Image size 2212x1659 · CFP: 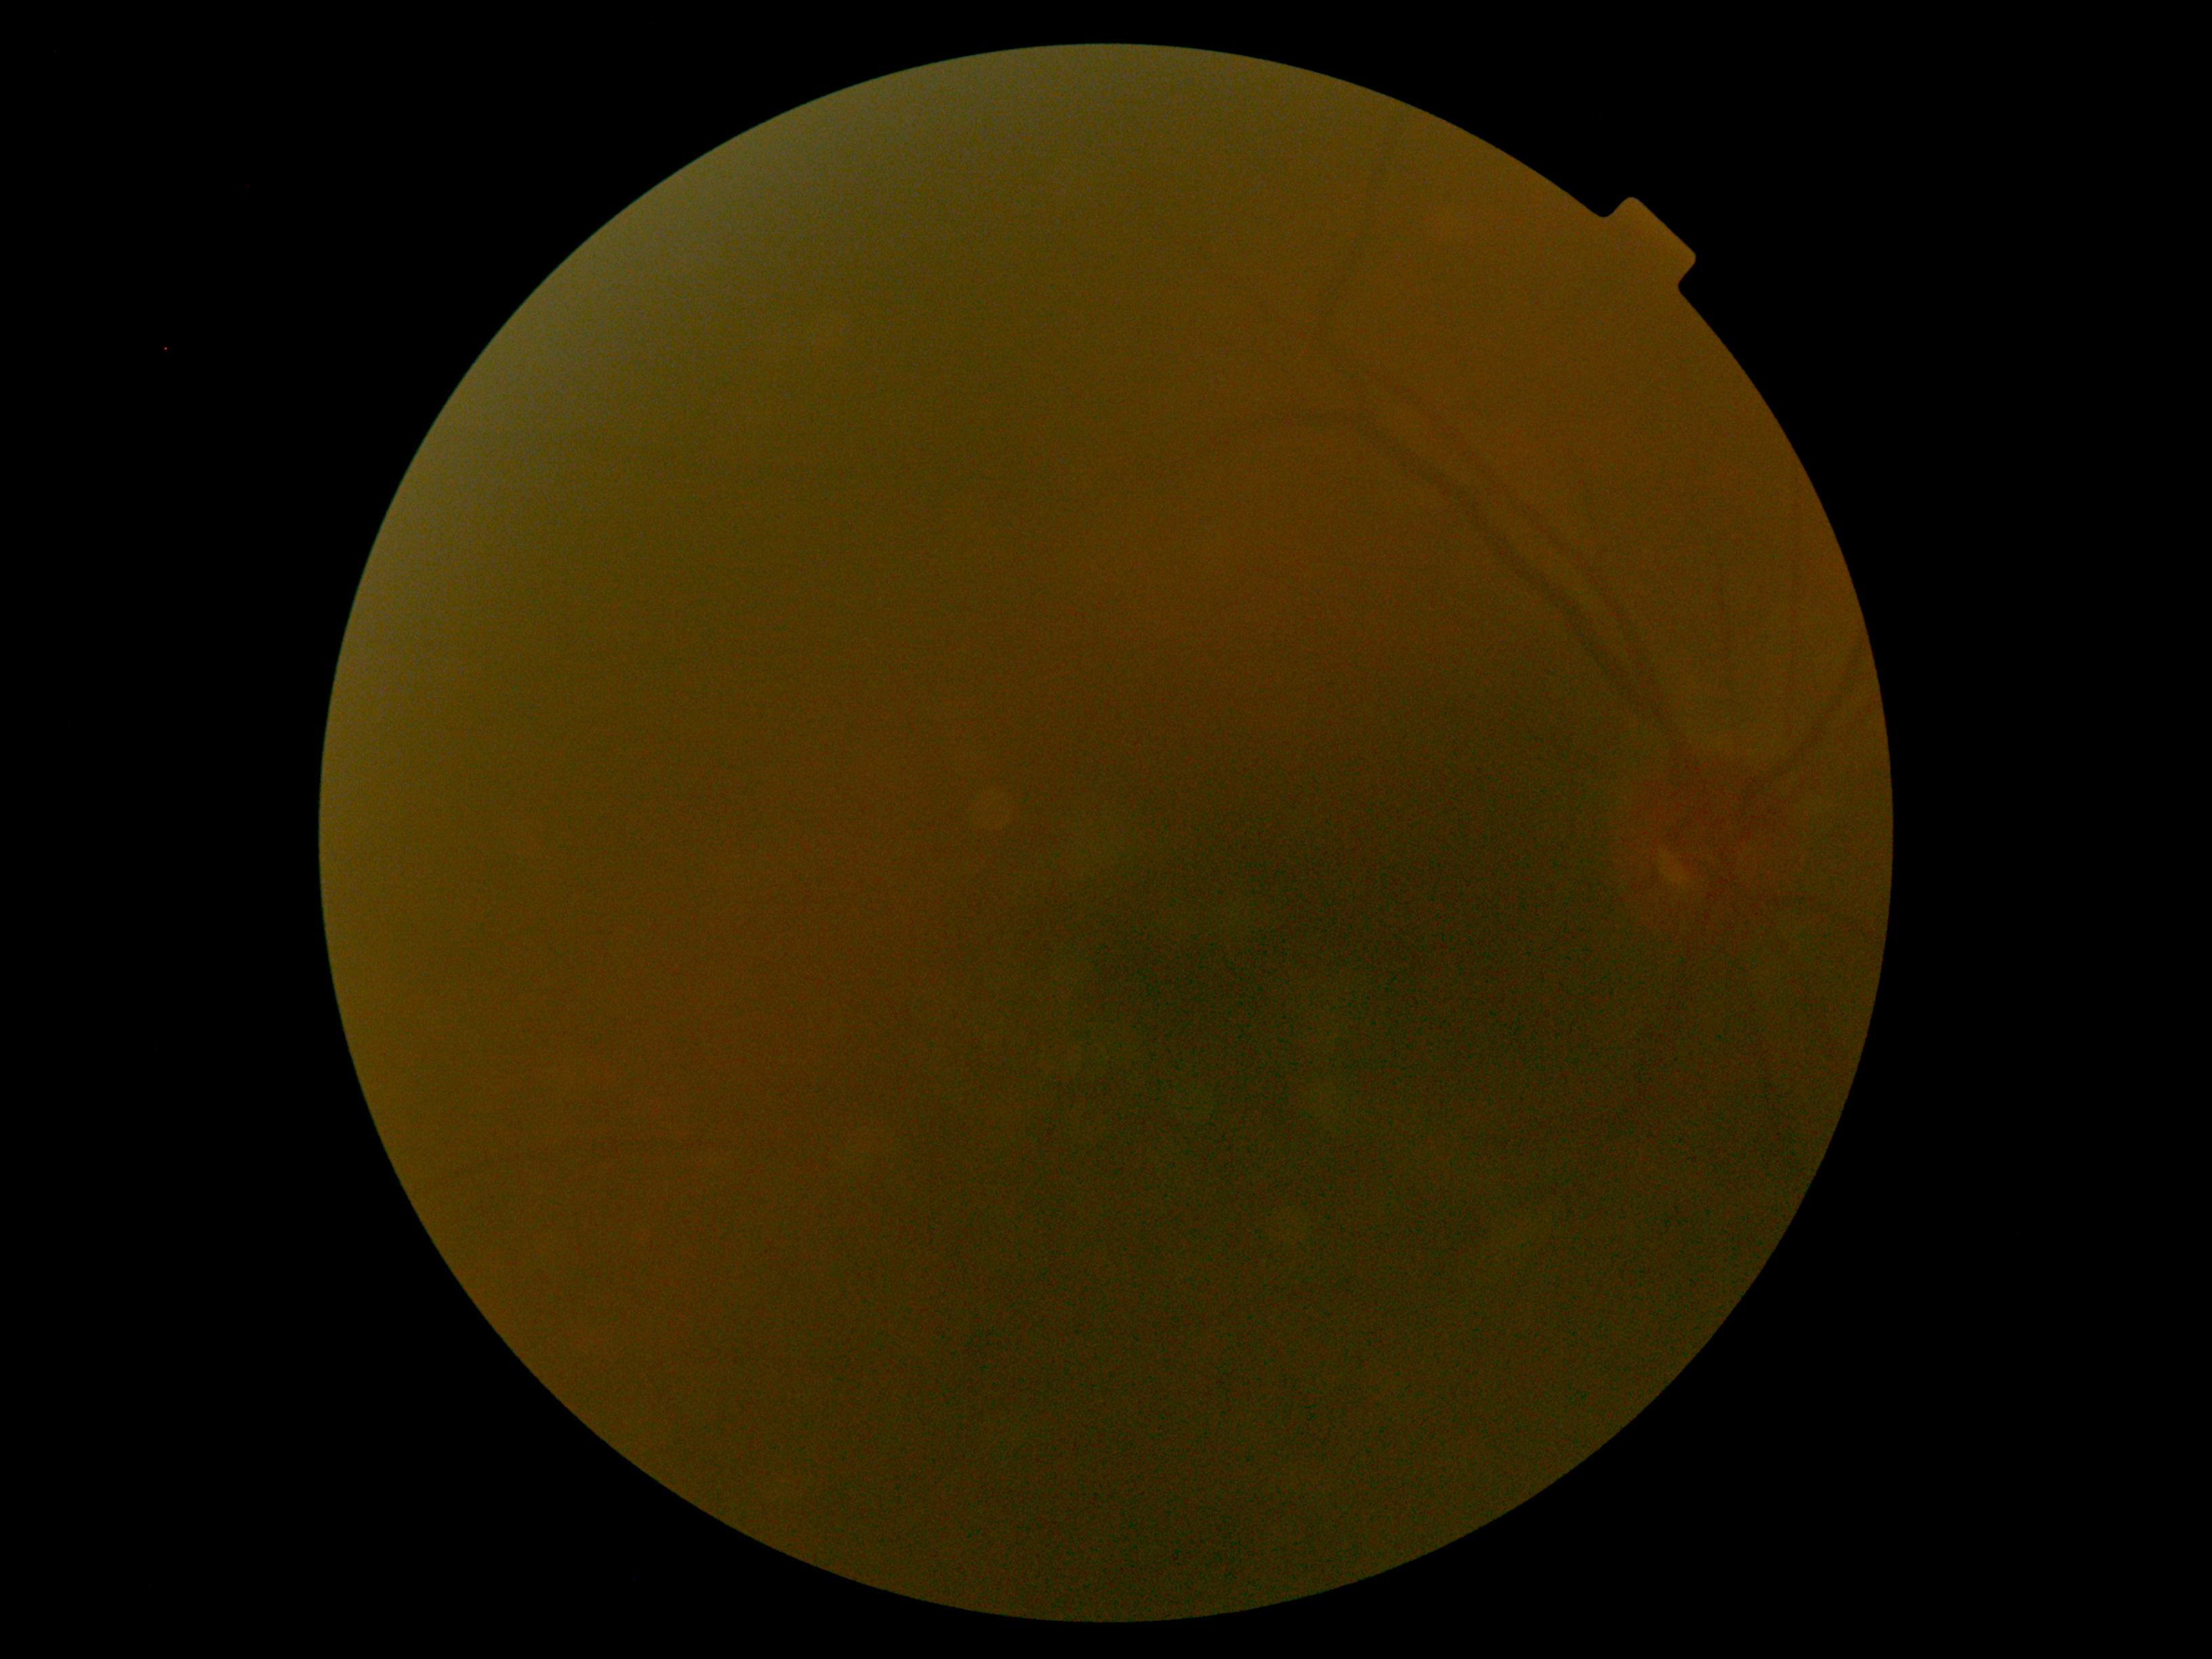
DR severity: ungradable due to poor image quality. Quality too poor to assess for DR.